Modified Davis grading — 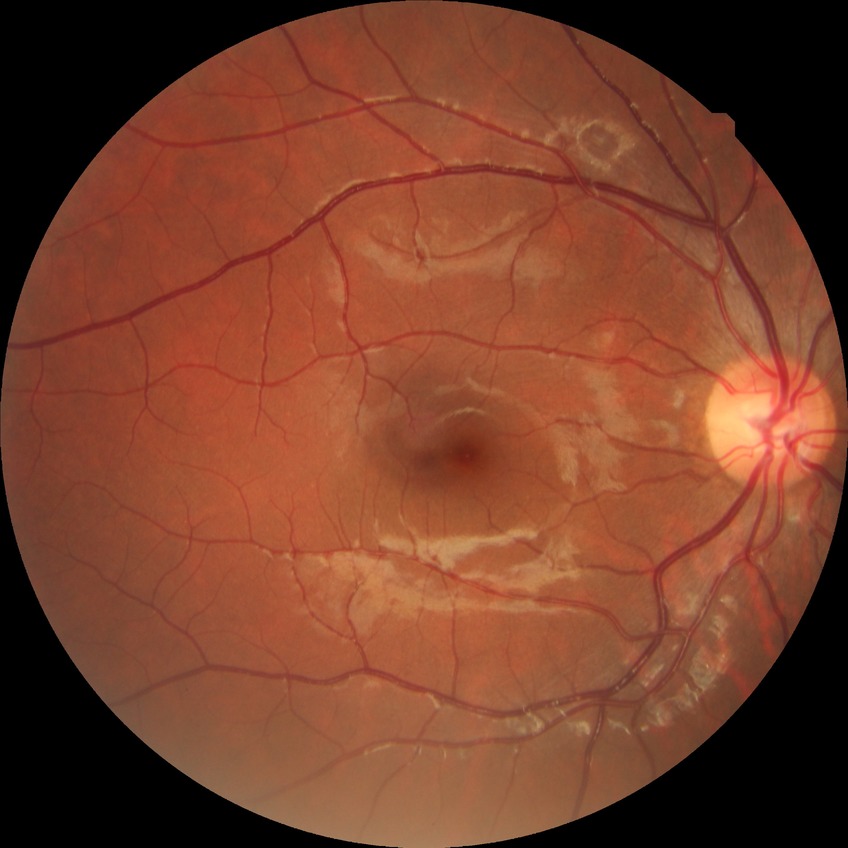
Modified Davis grading: no diabetic retinopathy.